2352x1568; 45° FOV
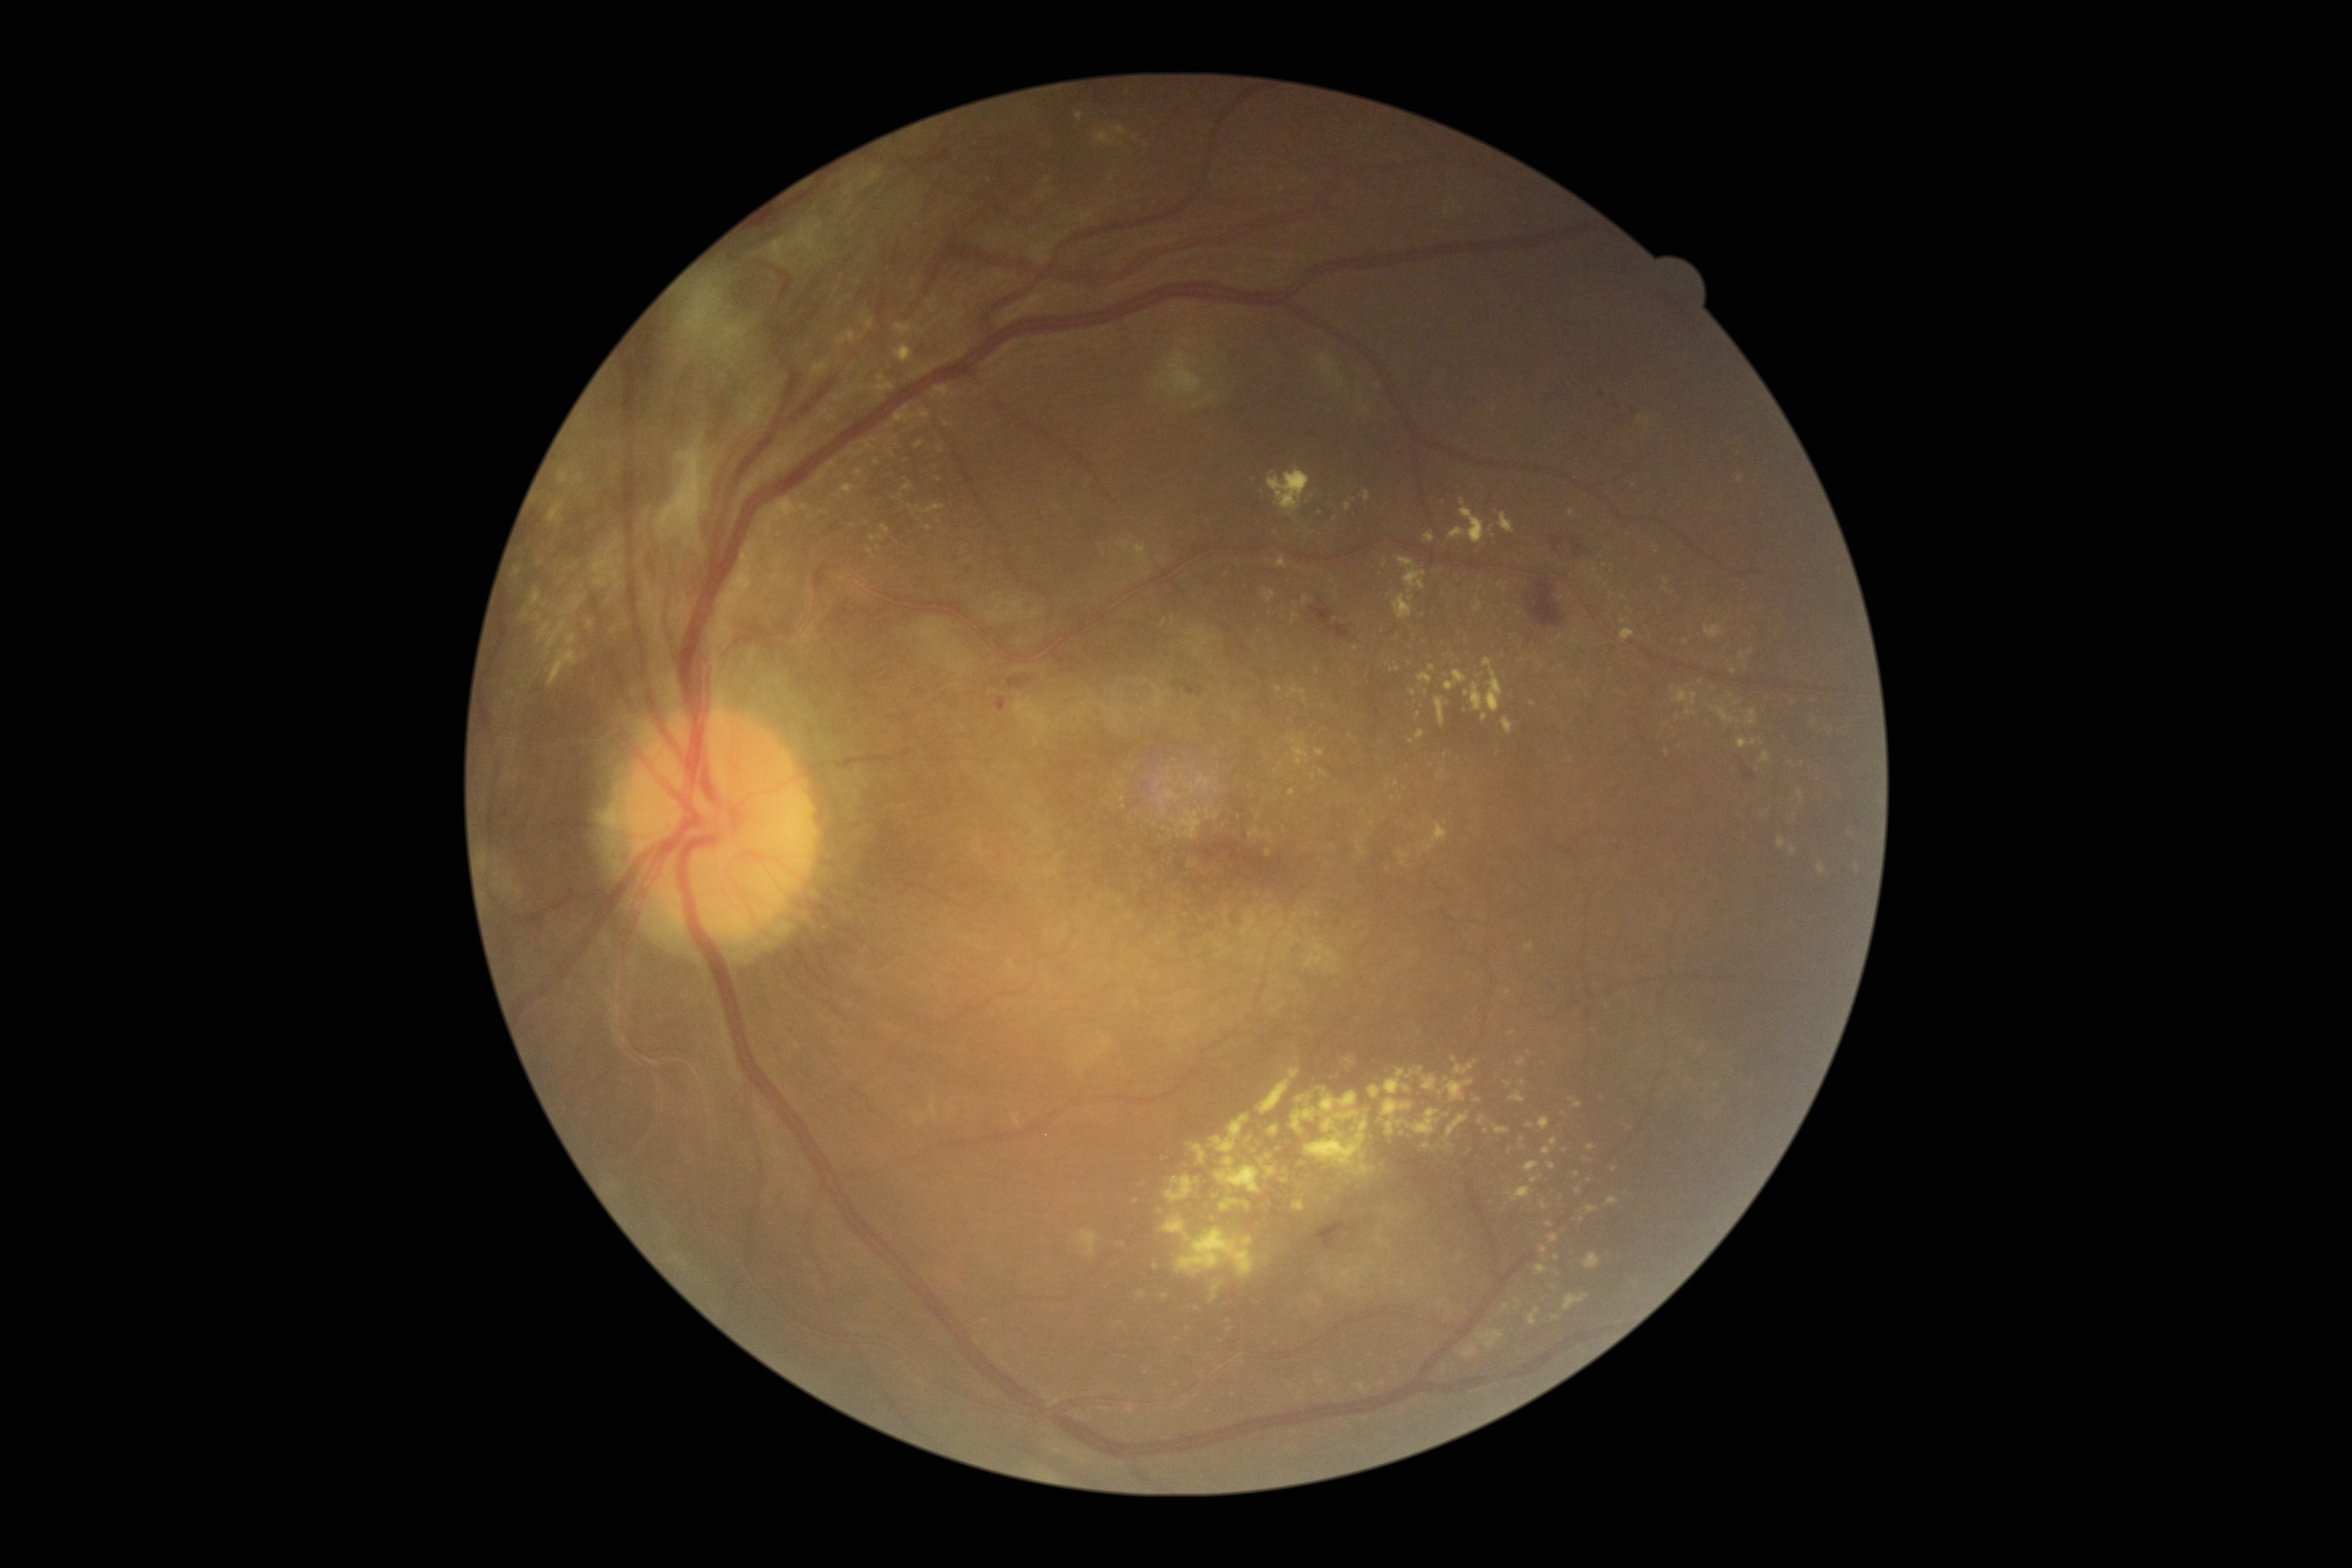 {"partial": true, "dr_grade": 4, "dr_grade_name": "PDR", "lesions": {"ex": [[1215, 1156, 1261, 1192], [856, 470, 866, 479], [1710, 705, 1734, 724], [1436, 696, 1445, 728], [1517, 1057, 1525, 1065], [1540, 1201, 1547, 1209], [845, 449, 863, 458], [1292, 1108, 1318, 1134], [841, 483, 854, 493], [1587, 1144, 1595, 1150], [1529, 1307, 1541, 1324]], "ex_small": [[1398, 1372], [1165, 1296], [910, 507], [1500, 584], [1554, 1286], [1366, 1263], [1261, 1160], [1519, 614]]}}